2212x1659, 45-degree field of view
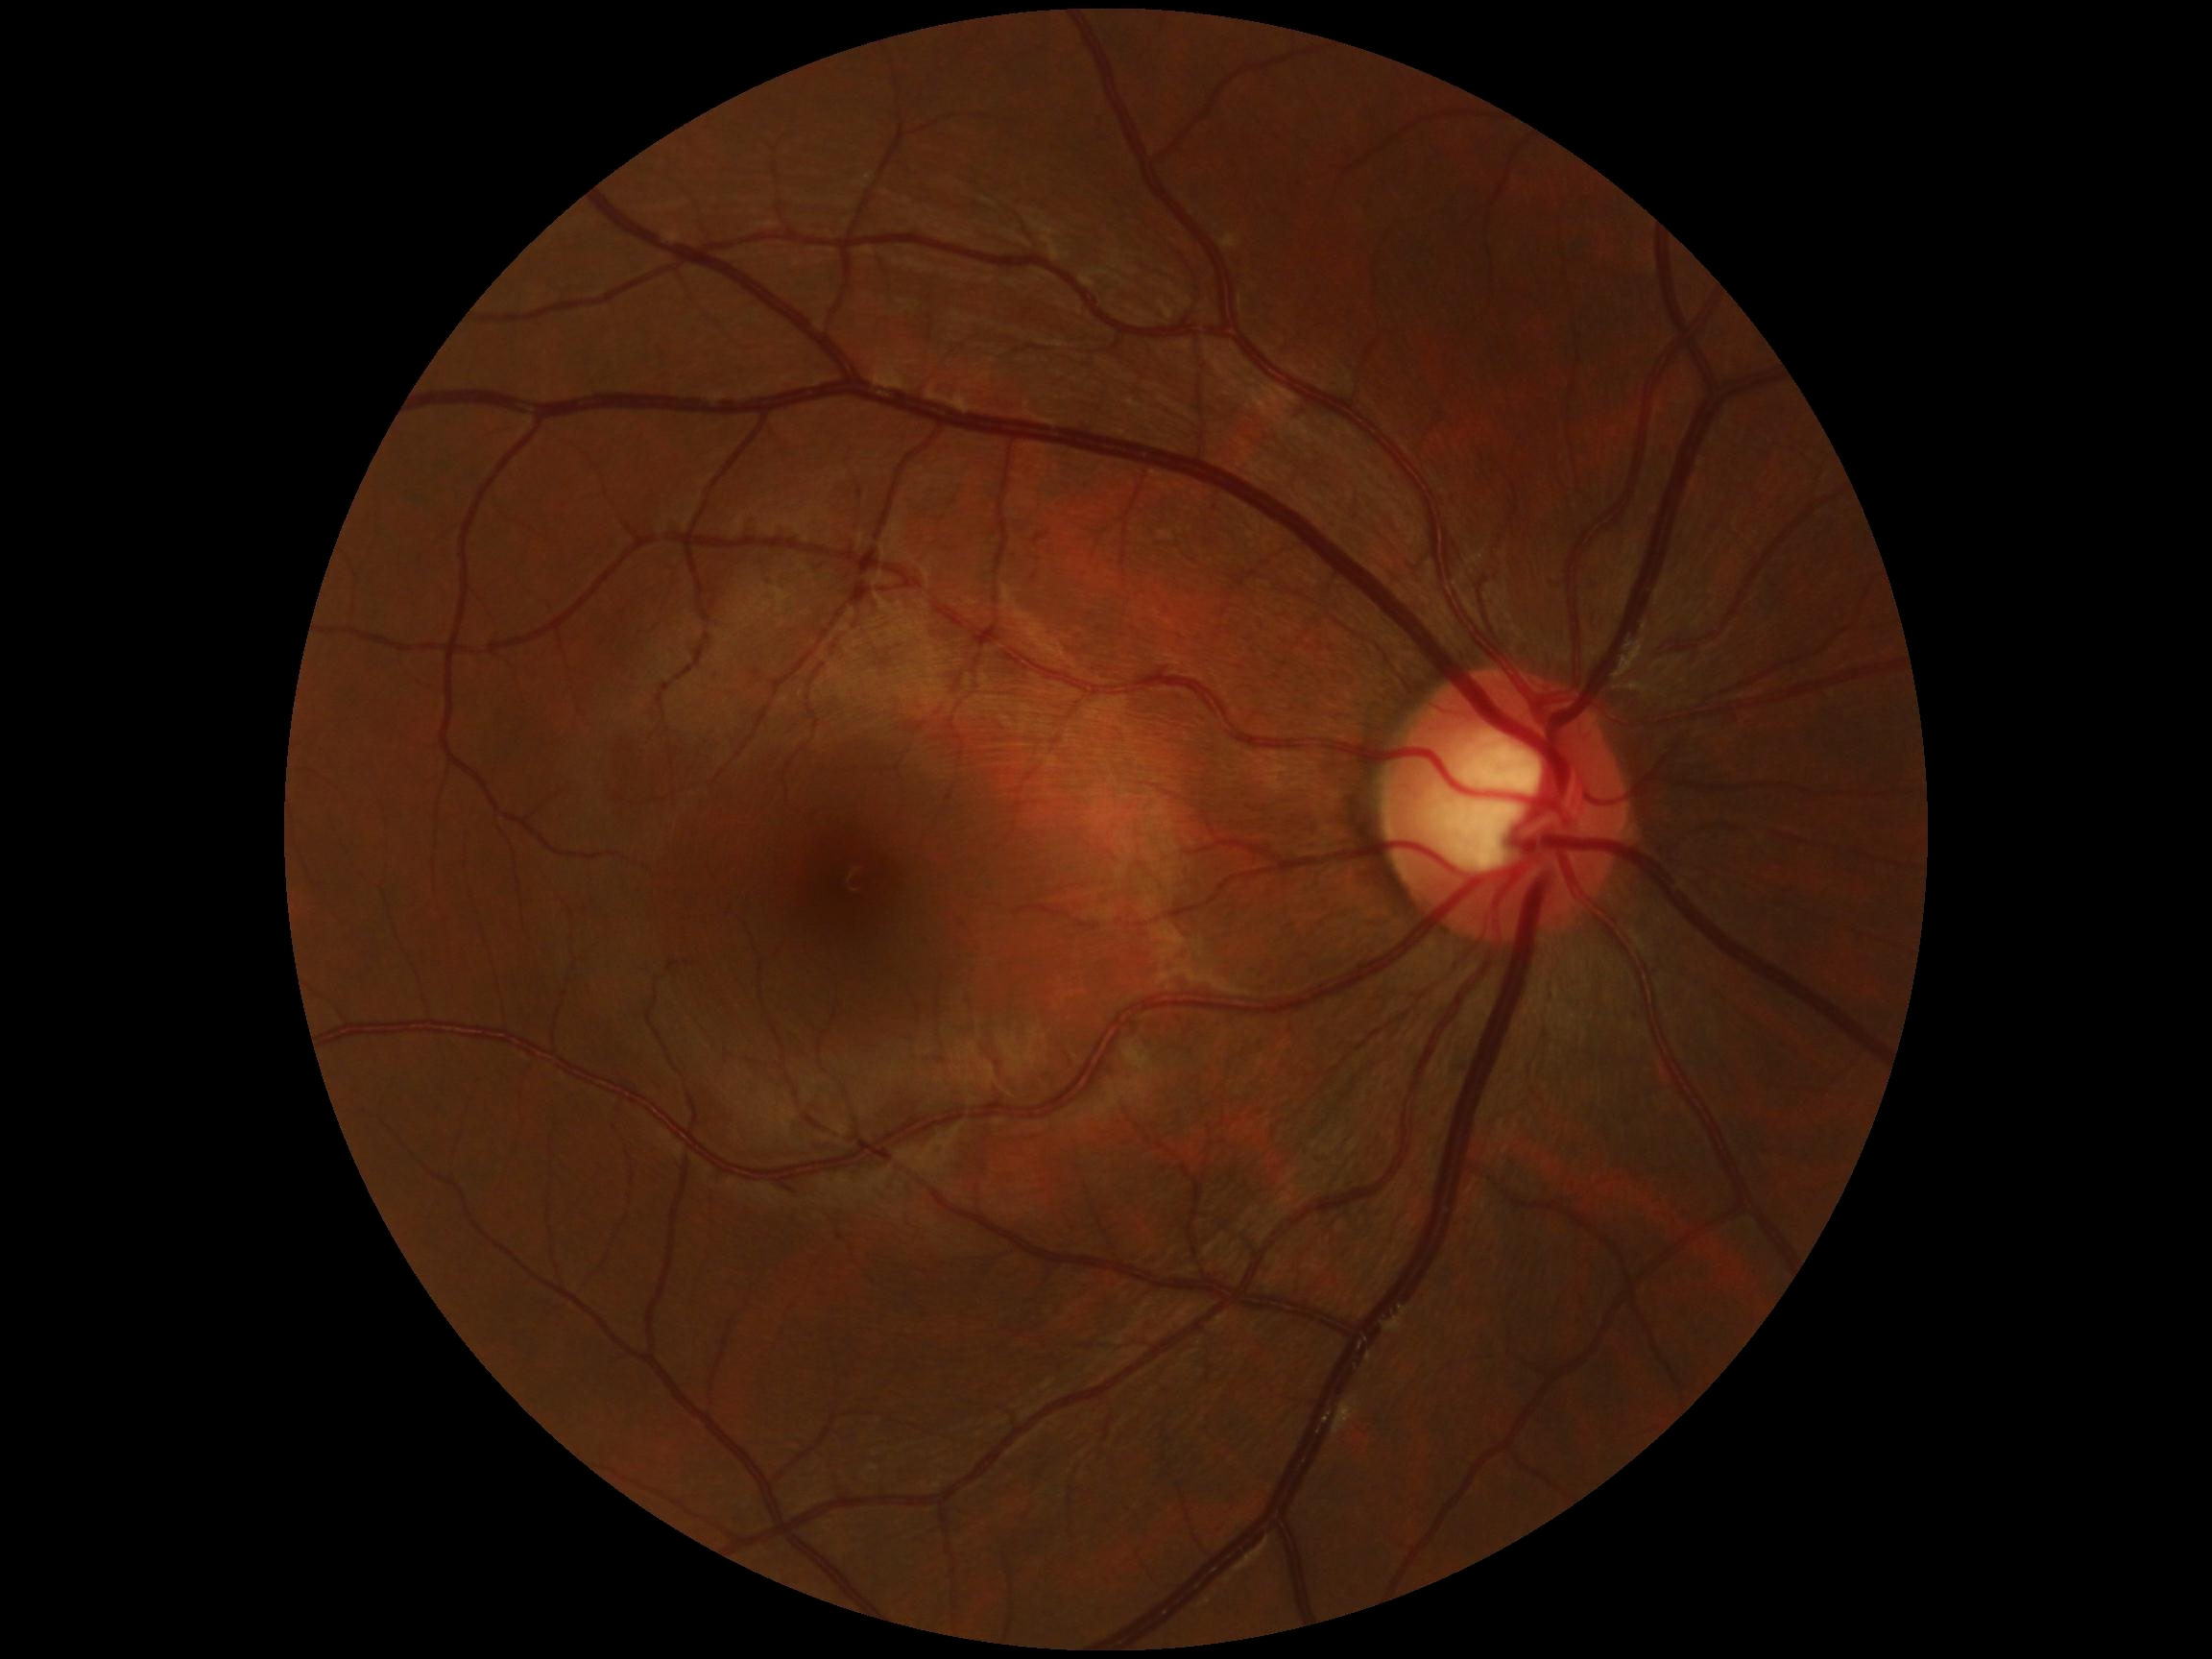 DR grade is 0.